640x480px. Infant wide-field fundus photograph. Captured with the Clarity RetCam 3 (130° field of view)
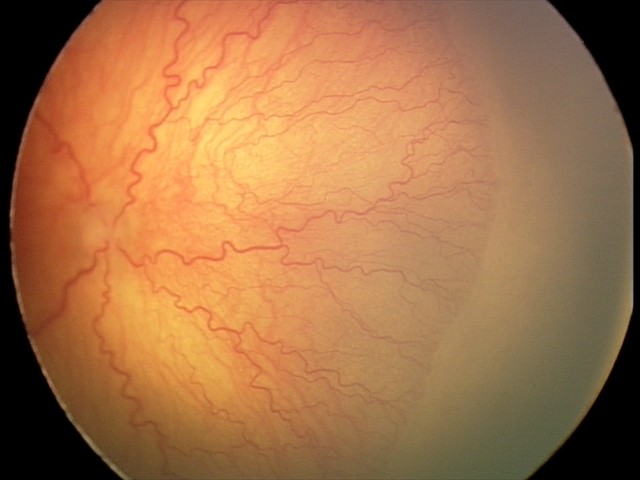

Screening series with A-ROP (aggressive ROP) — rapidly progressive severe ROP with prominent plus disease, often without classic stage progression.